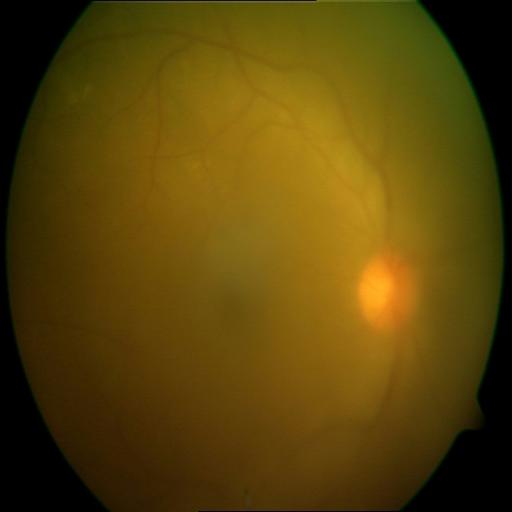 Diagnosis: media haze (MH).